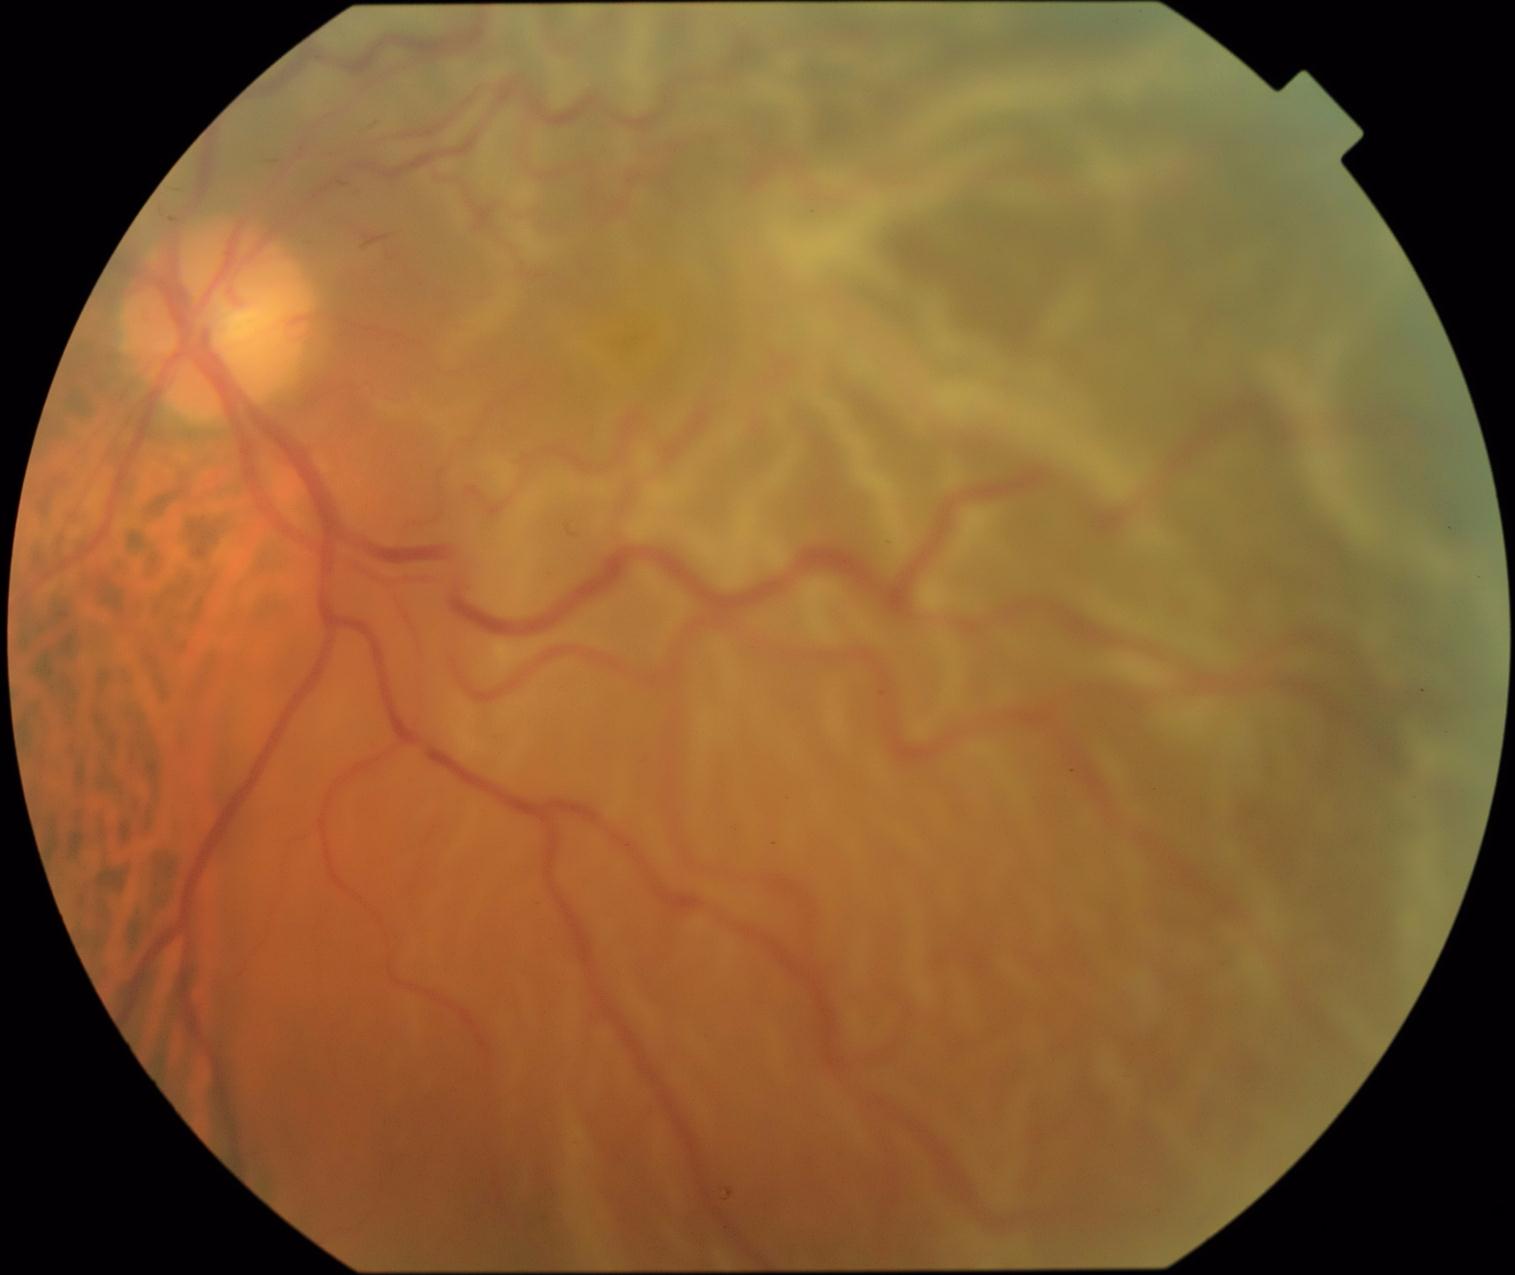

DR grade: 4.